45° field of view
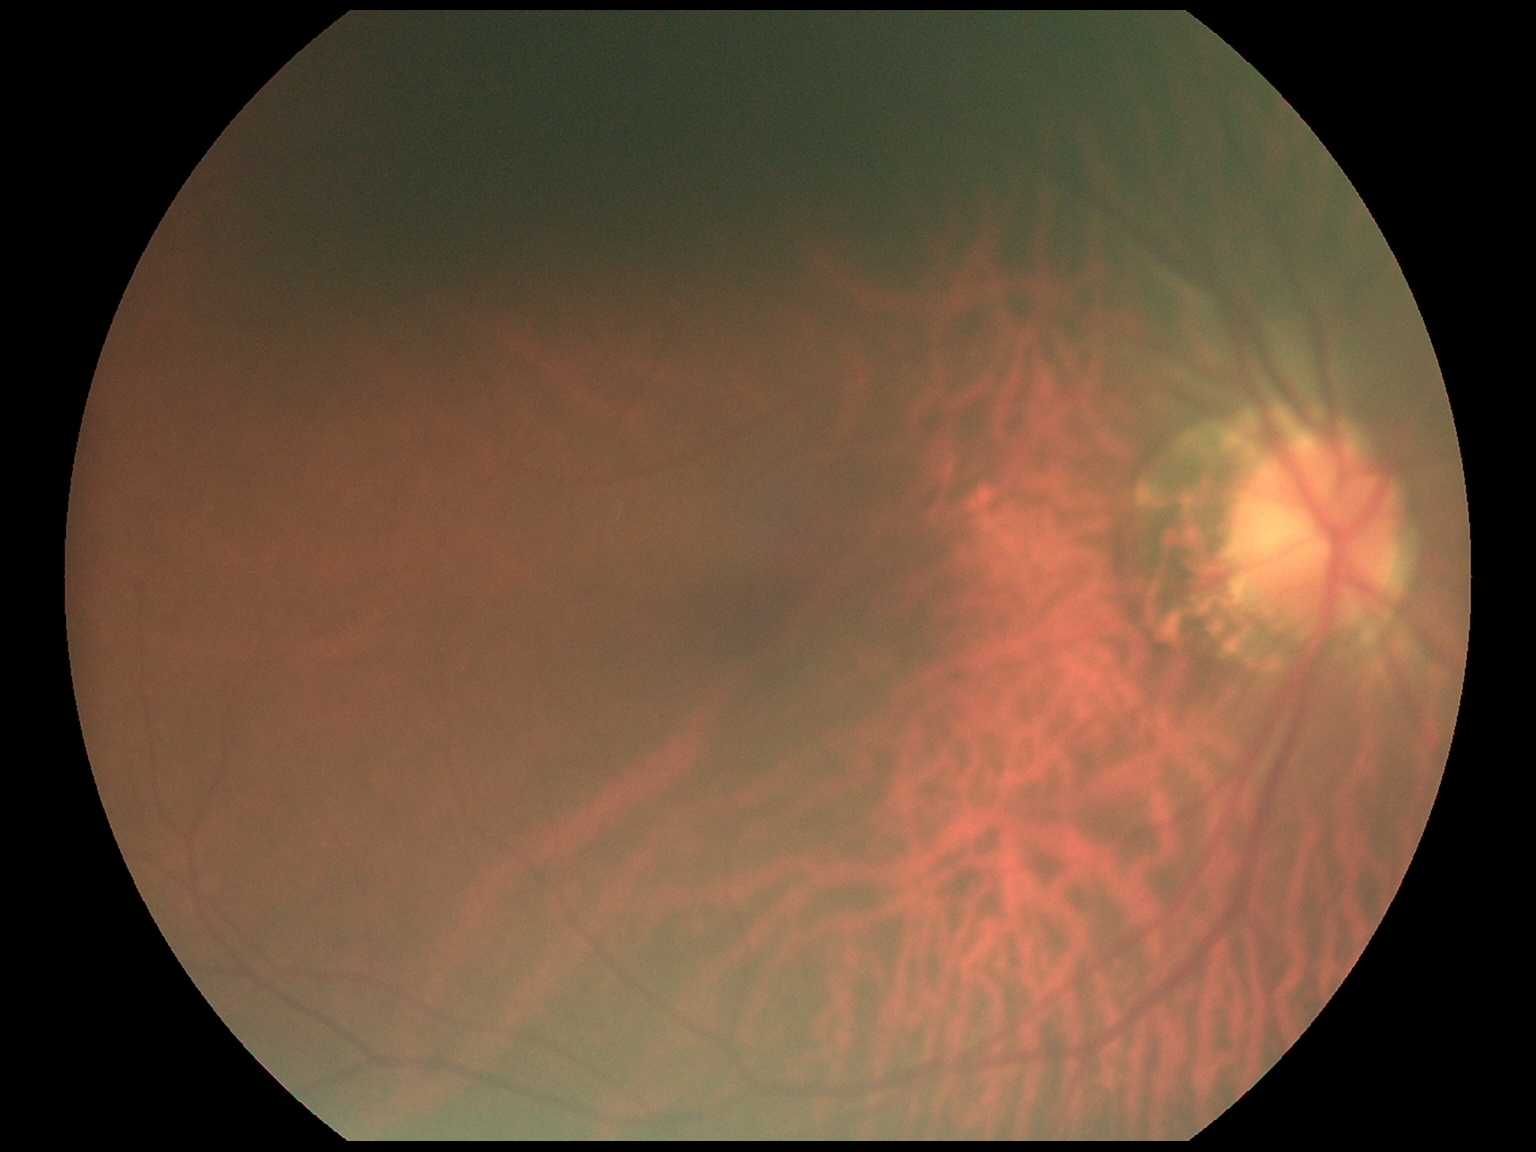

Diabetic retinopathy (DR) is no apparent retinopathy (grade 0).